848x848.
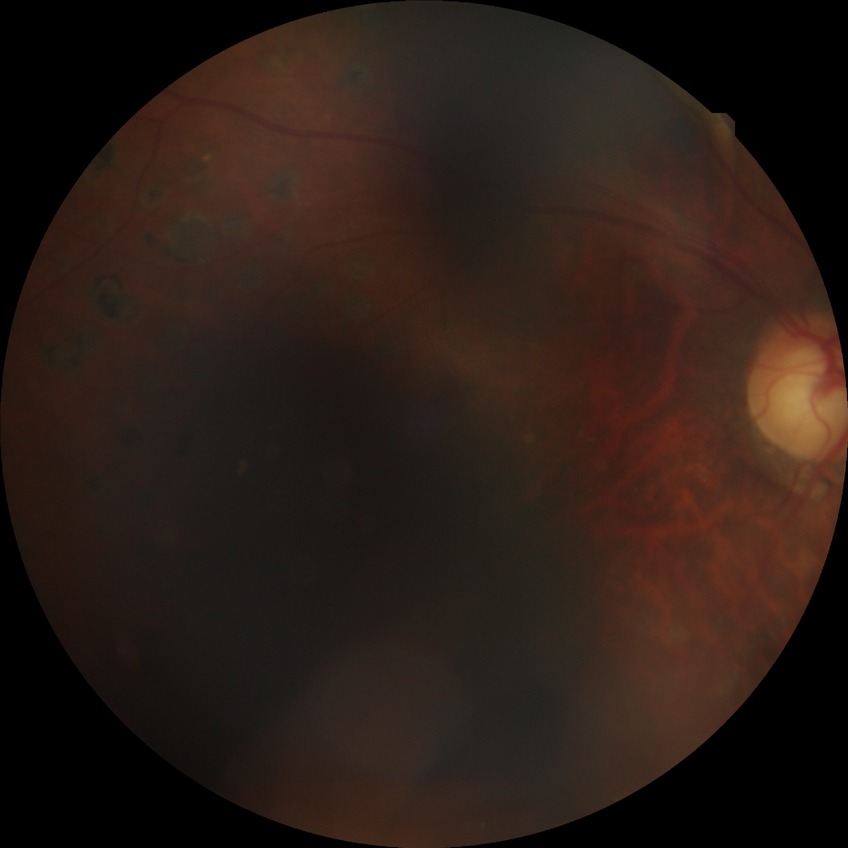
Diabetic retinopathy (DR) is proliferative diabetic retinopathy (PDR).